Image size 2212x1659; portable fundus photograph: 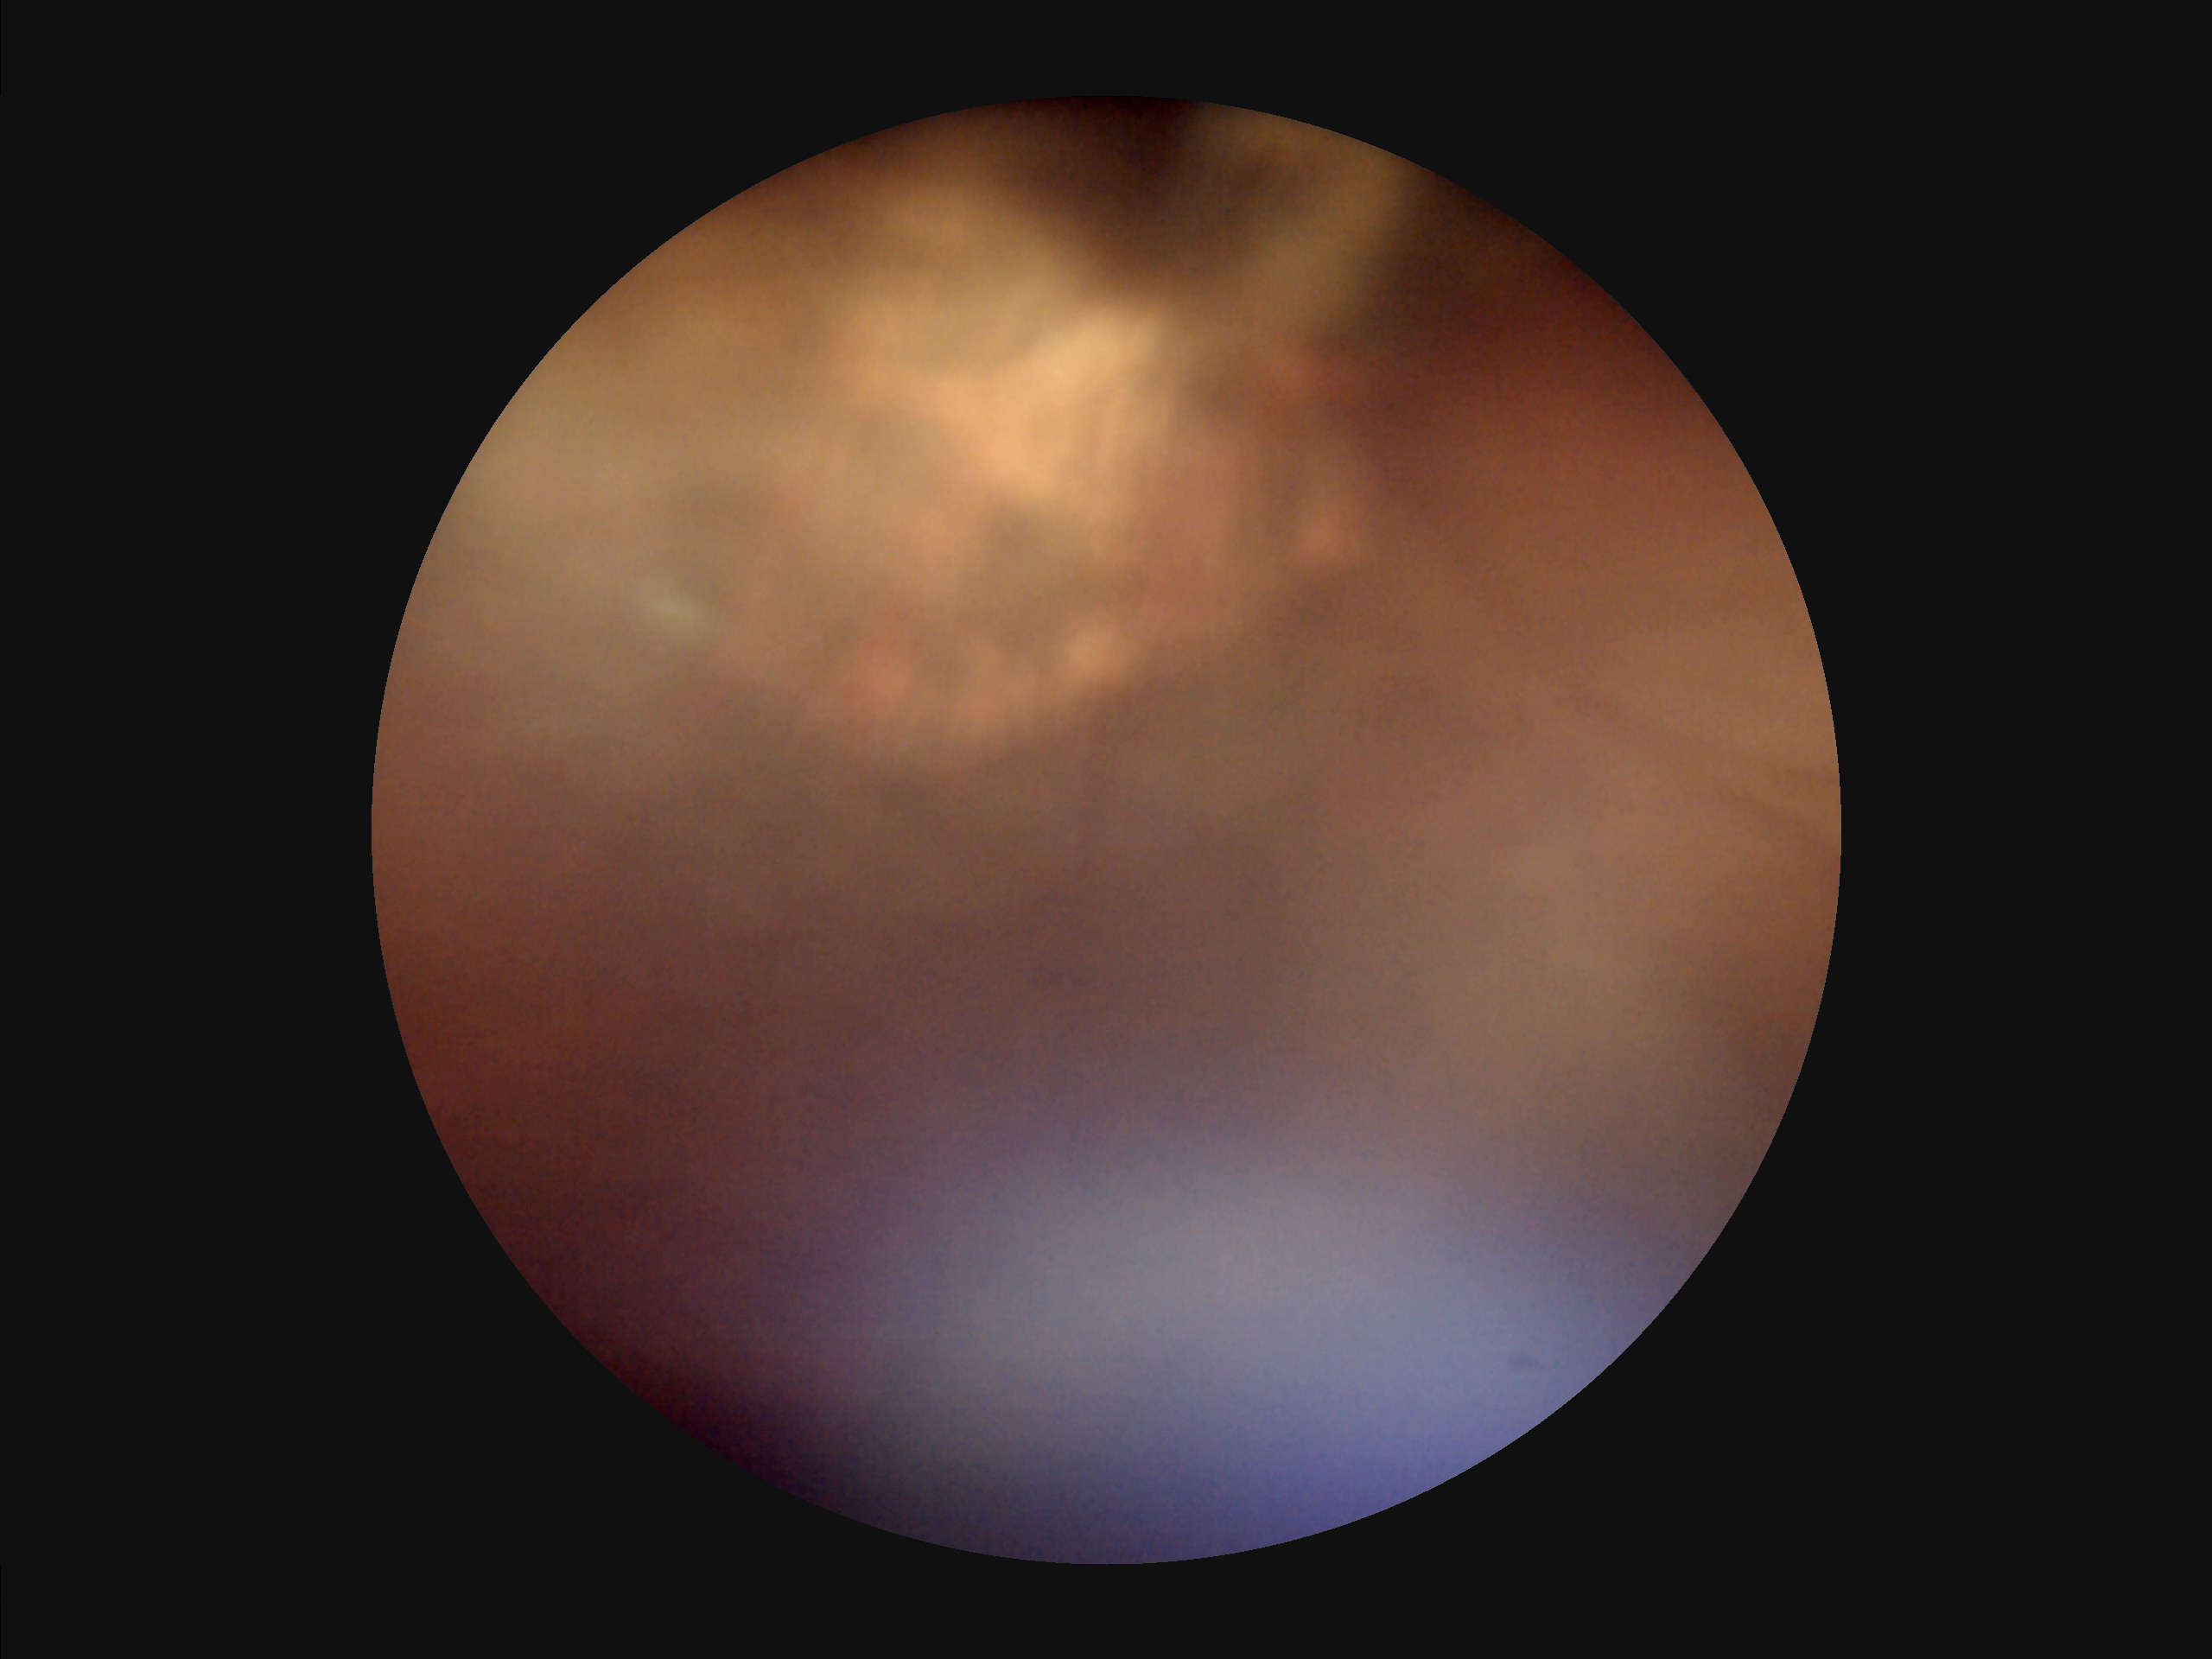
Image quality: focus: noticeable blur in the optic disc, vessels, or background; illumination: uneven illumination or color cast; contrast: narrow intensity range, structures hard to distinguish; overall: inadequate for clinical interpretation.